45° FOV · 1932x1916px: 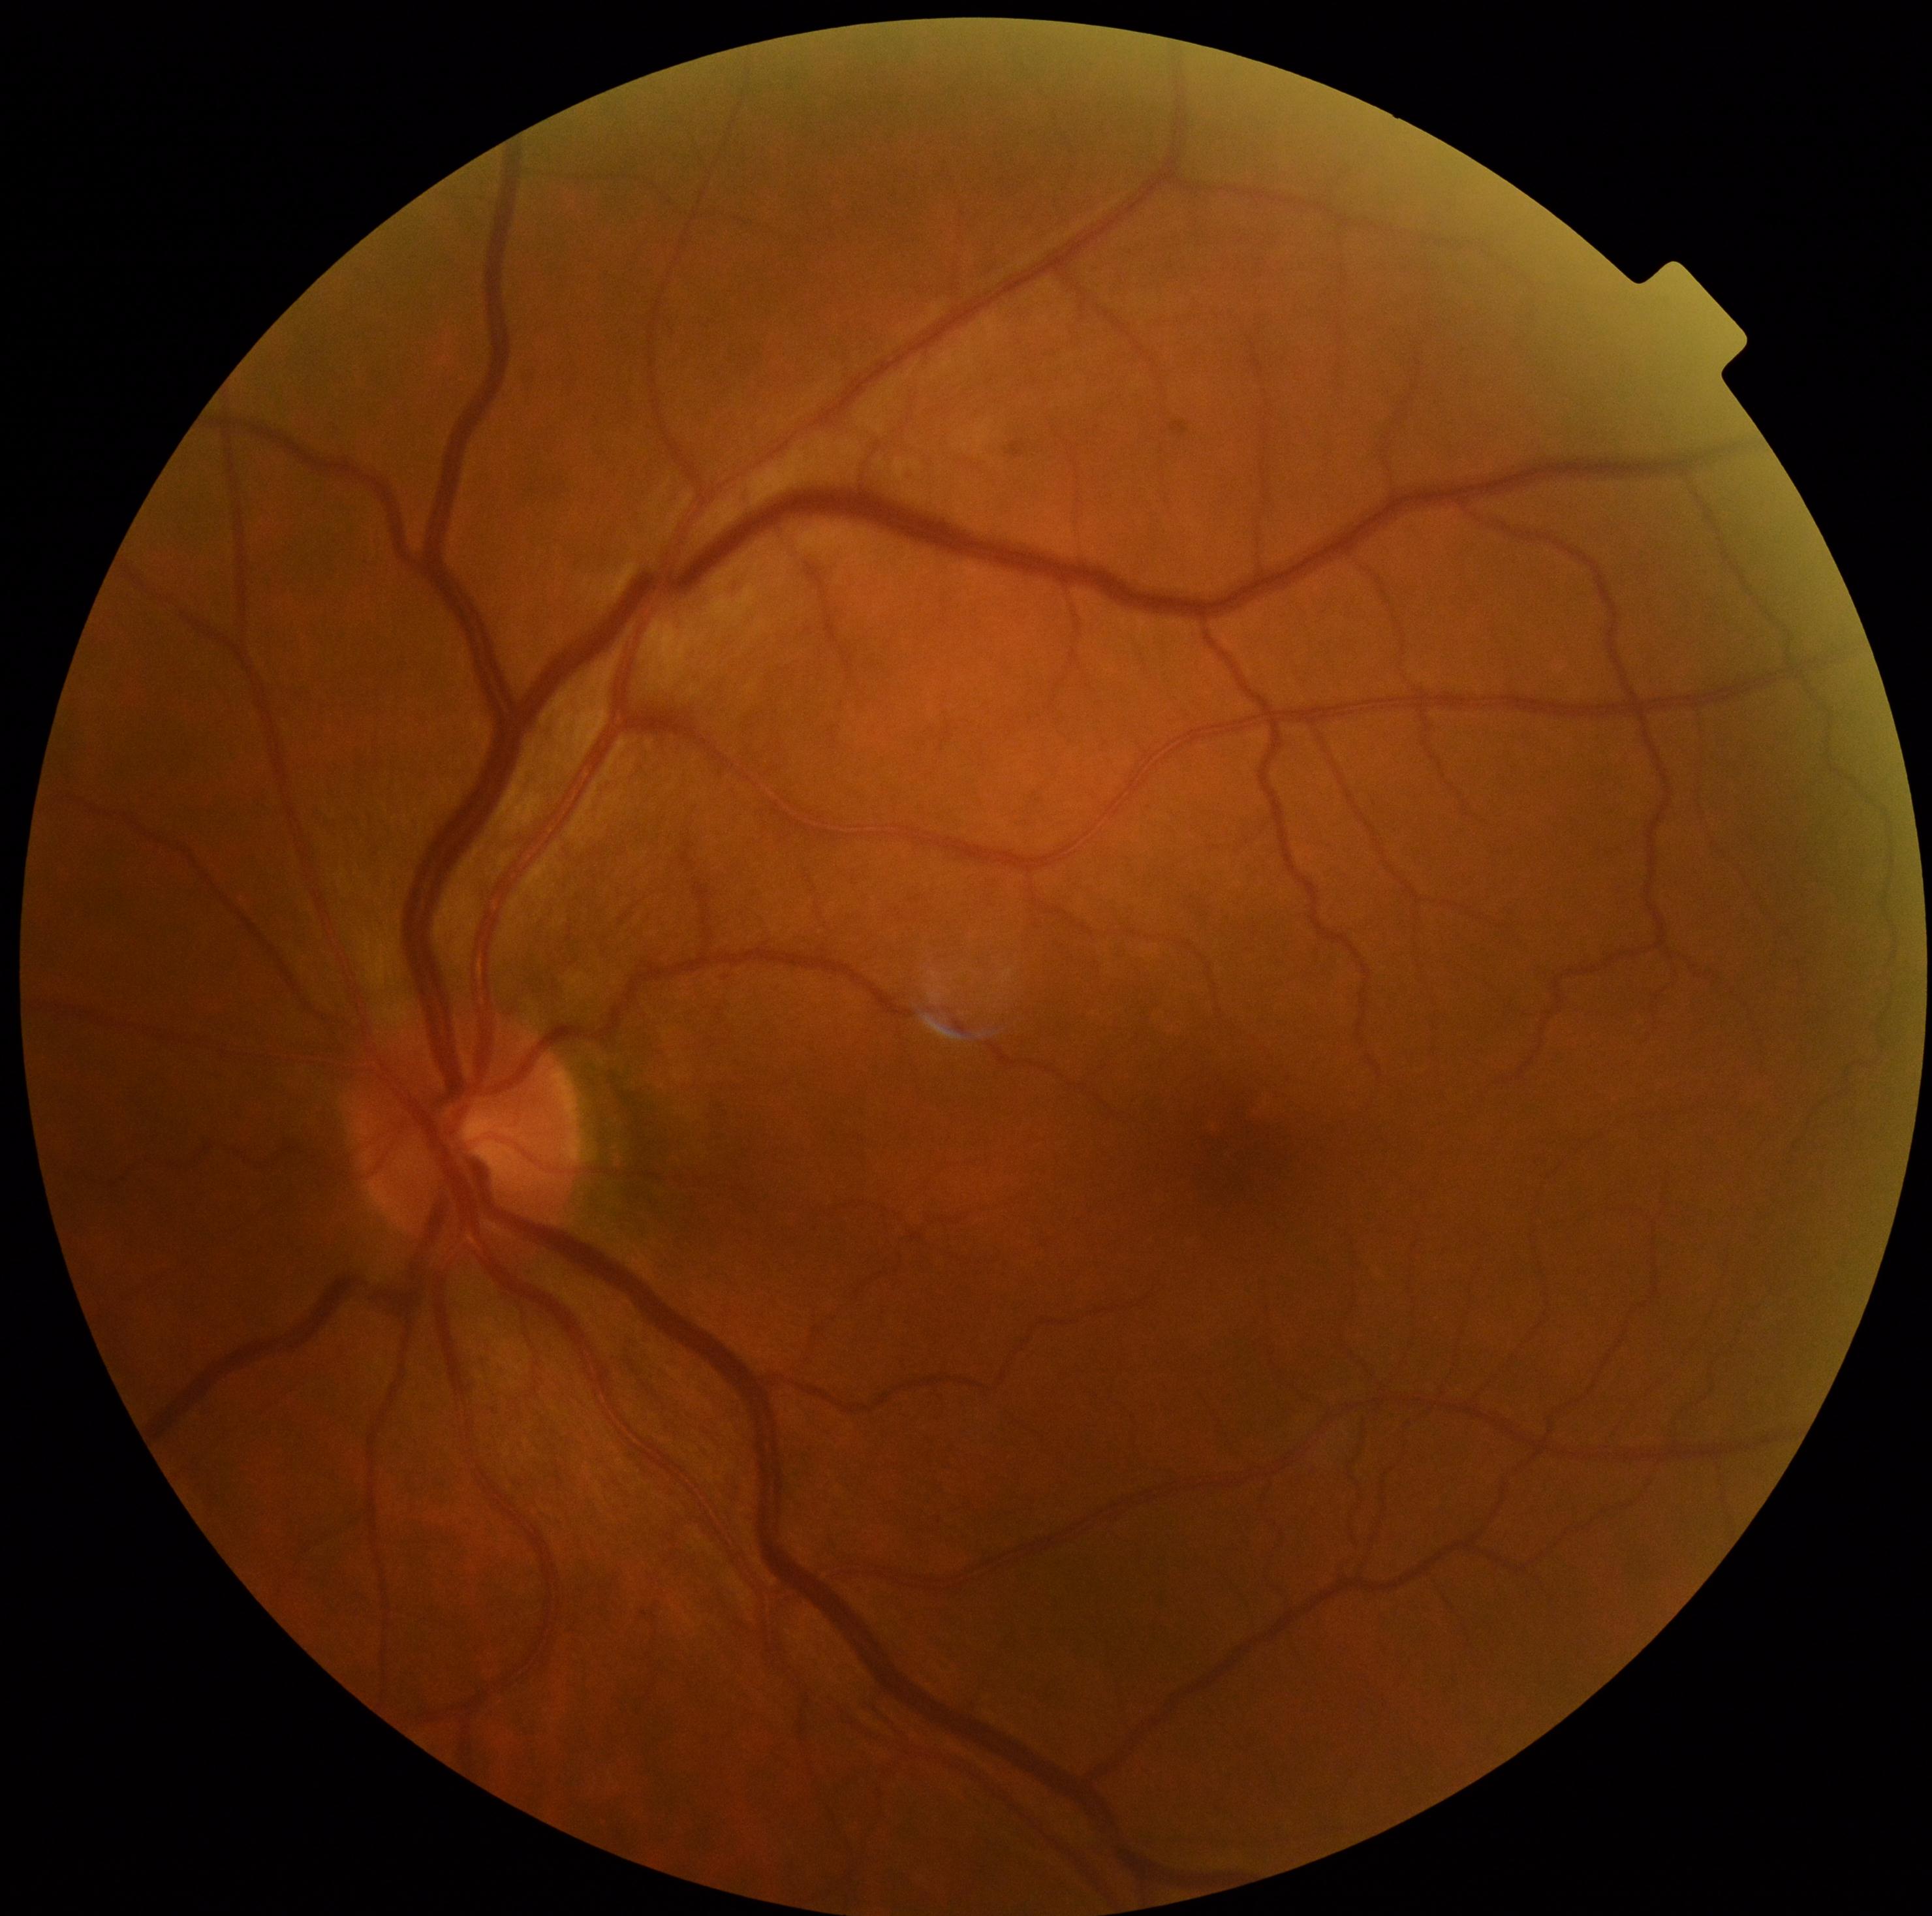
DR grade: no apparent retinopathy (0).
No DR findings.